848 x 848 pixels; NIDEK AFC-230 fundus camera: 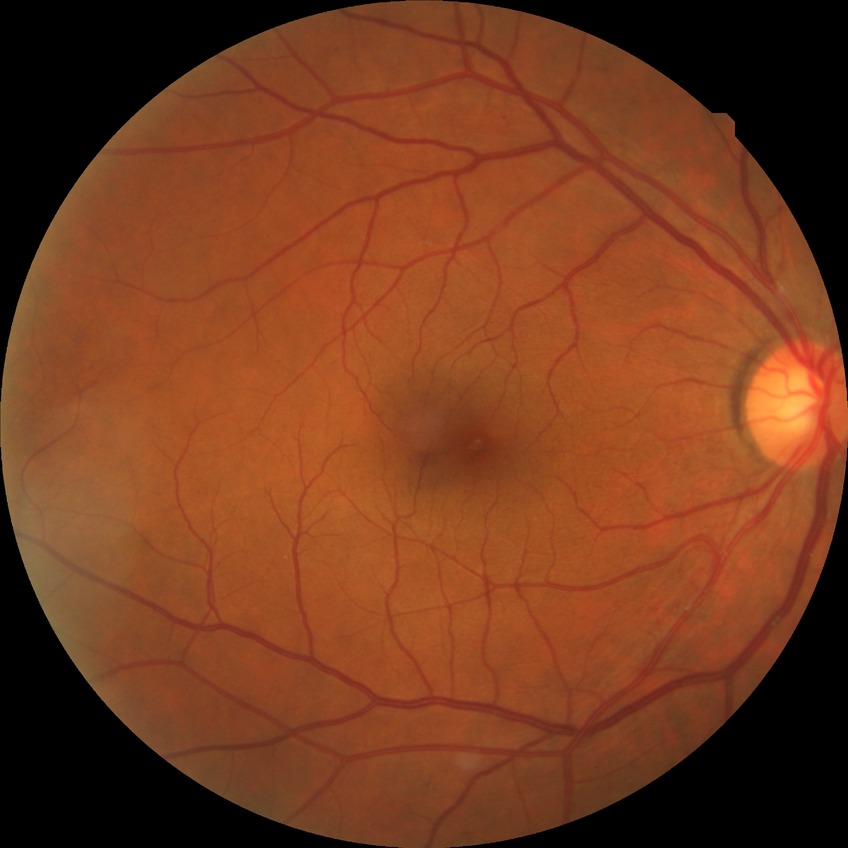
{"davis_grade": "simple diabetic retinopathy"}